1240x1240px; captured with the Phoenix ICON (100° field of view); wide-field contact fundus photograph of an infant
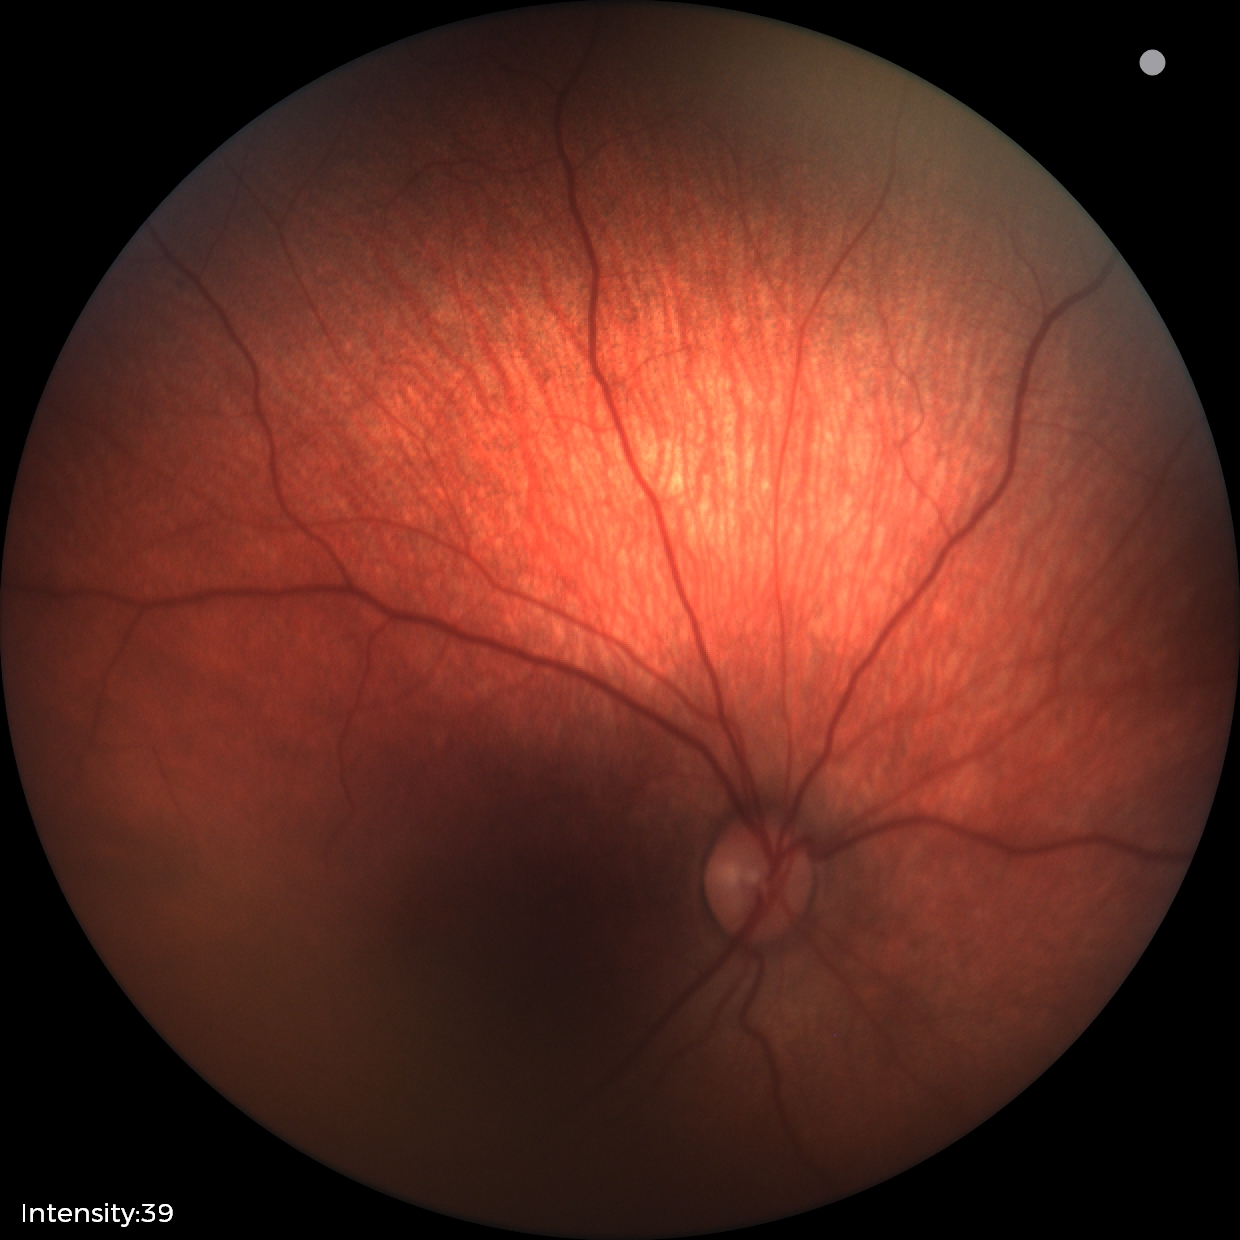 Normal screening examination.